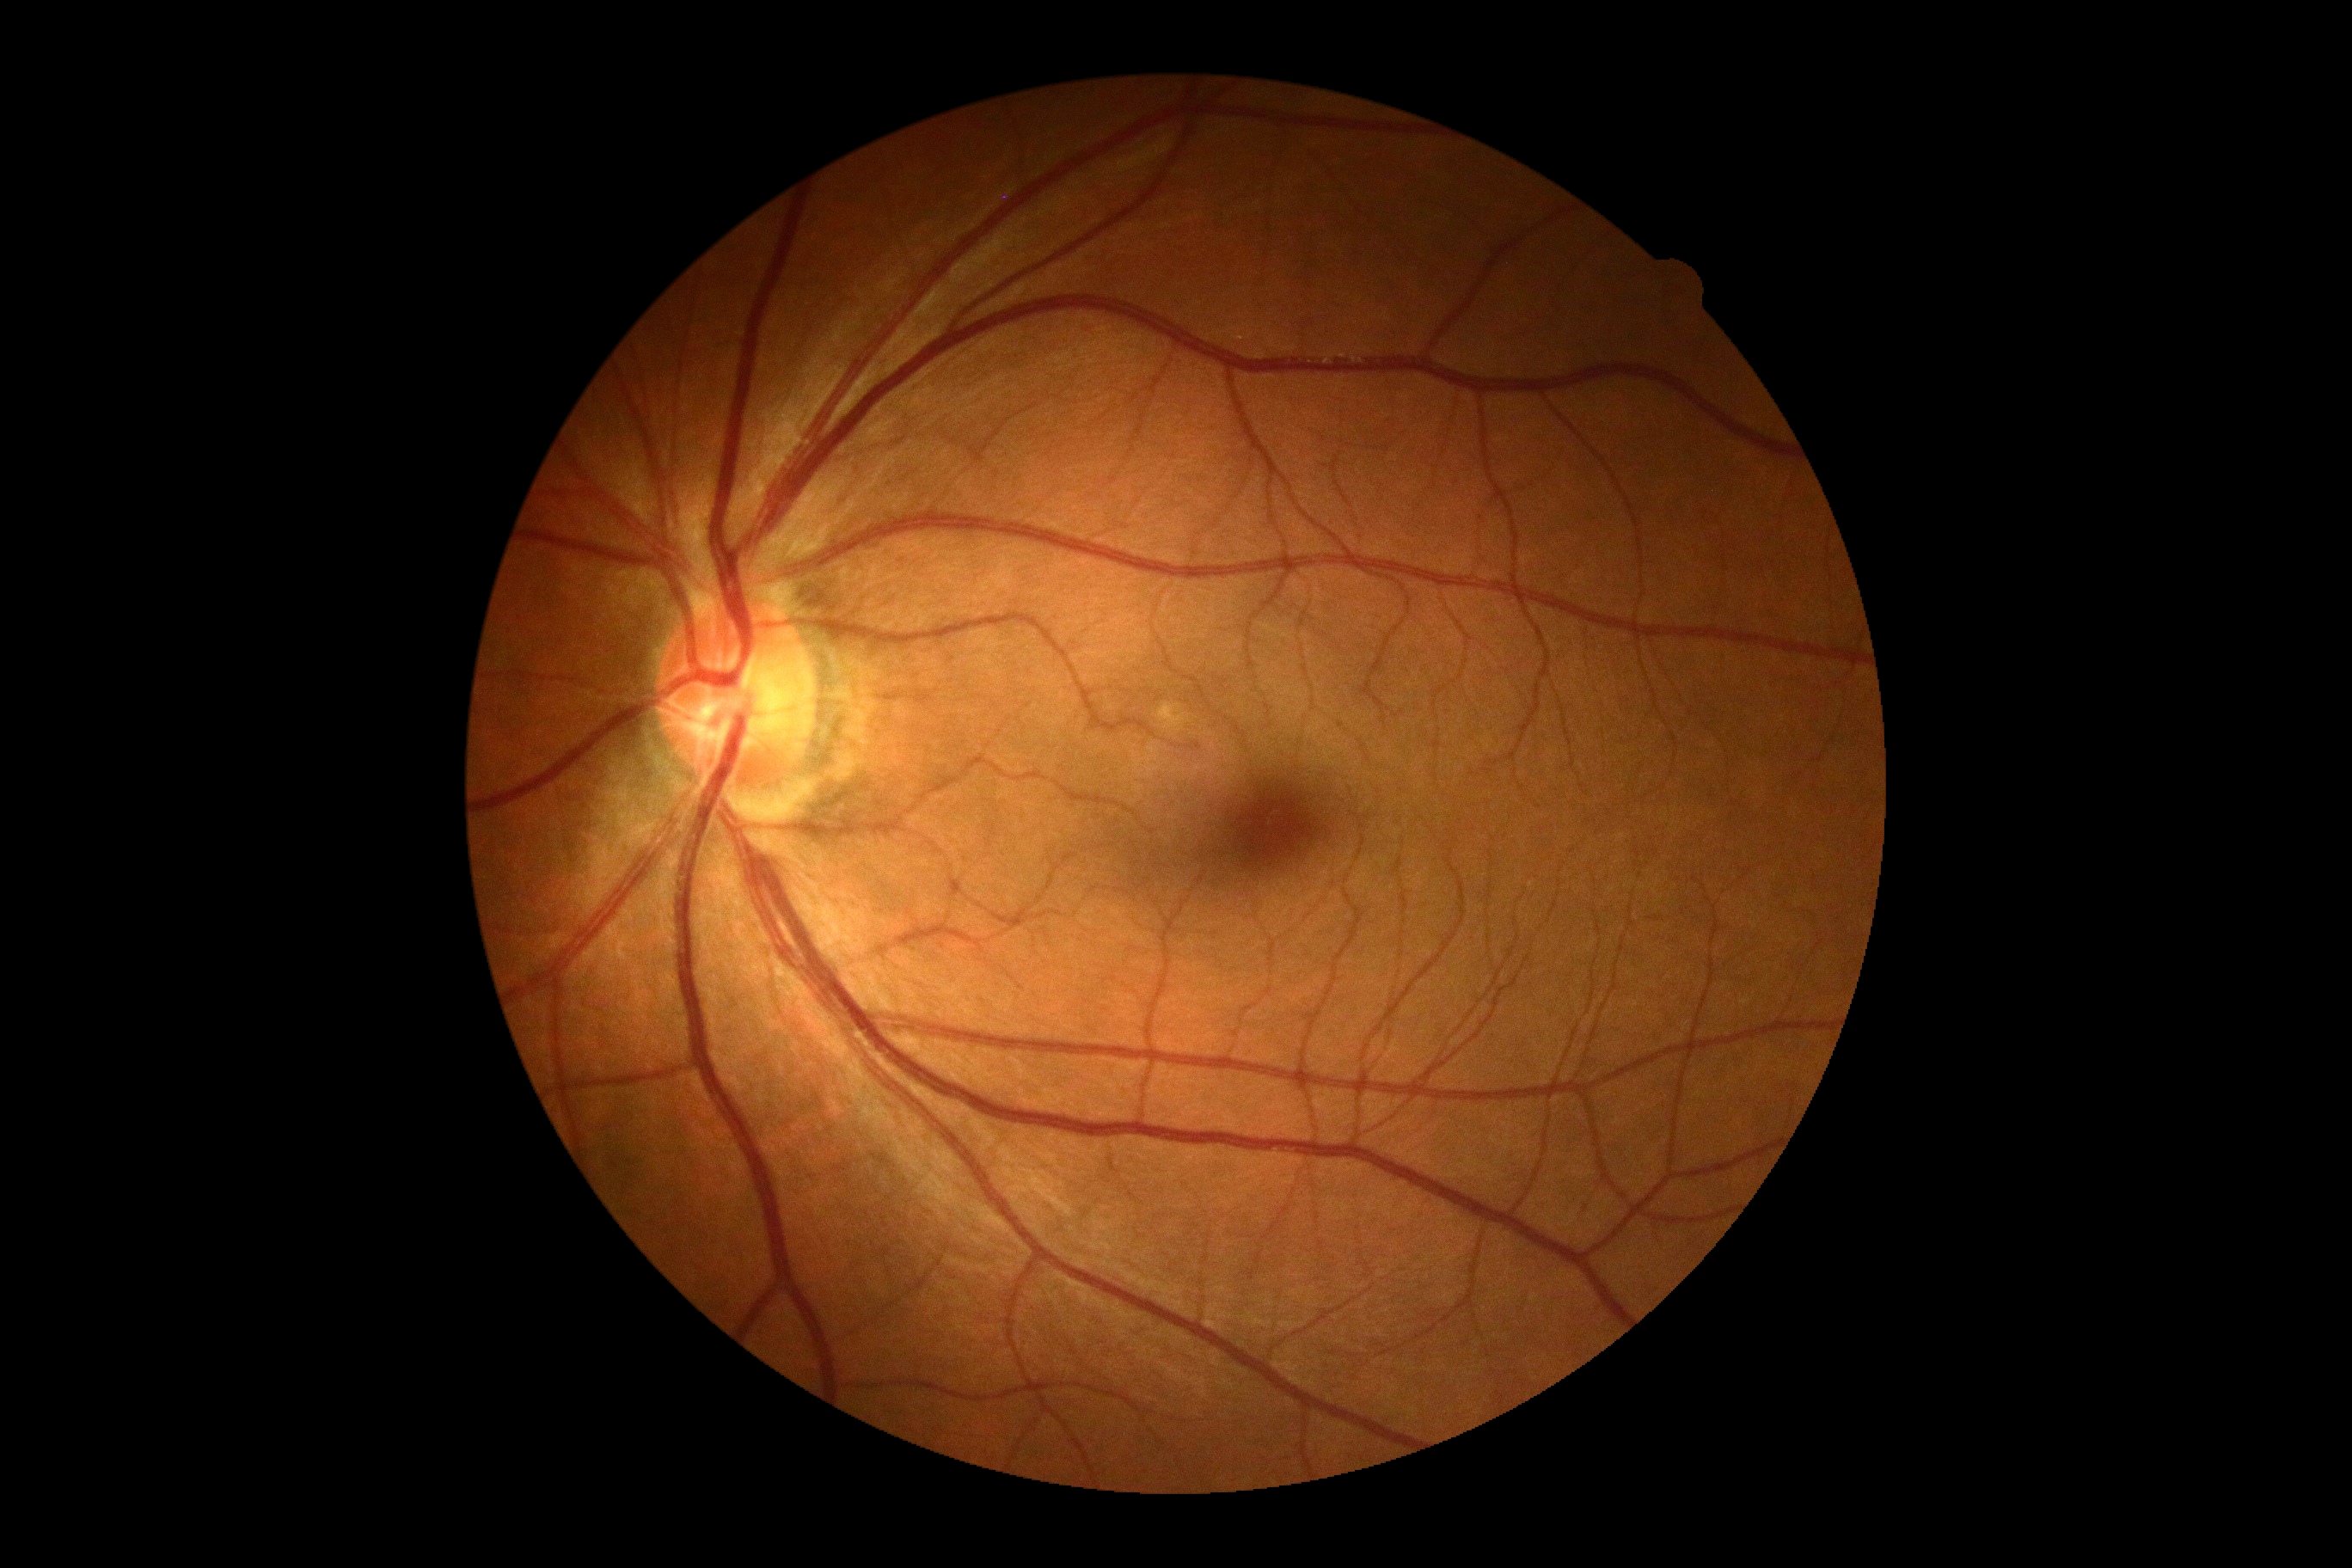

Retinopathy grade is 0 (no apparent retinopathy).